Acquired on the Clarity RetCam 3. Wide-field contact fundus photograph of an infant. 640x480: 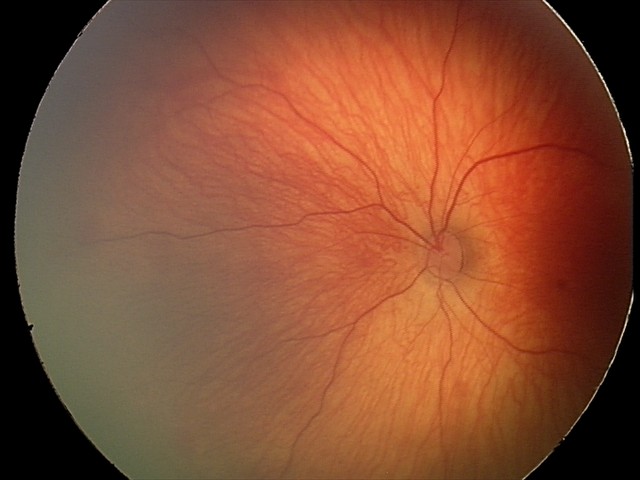

Screening series with retinal hemorrhages.